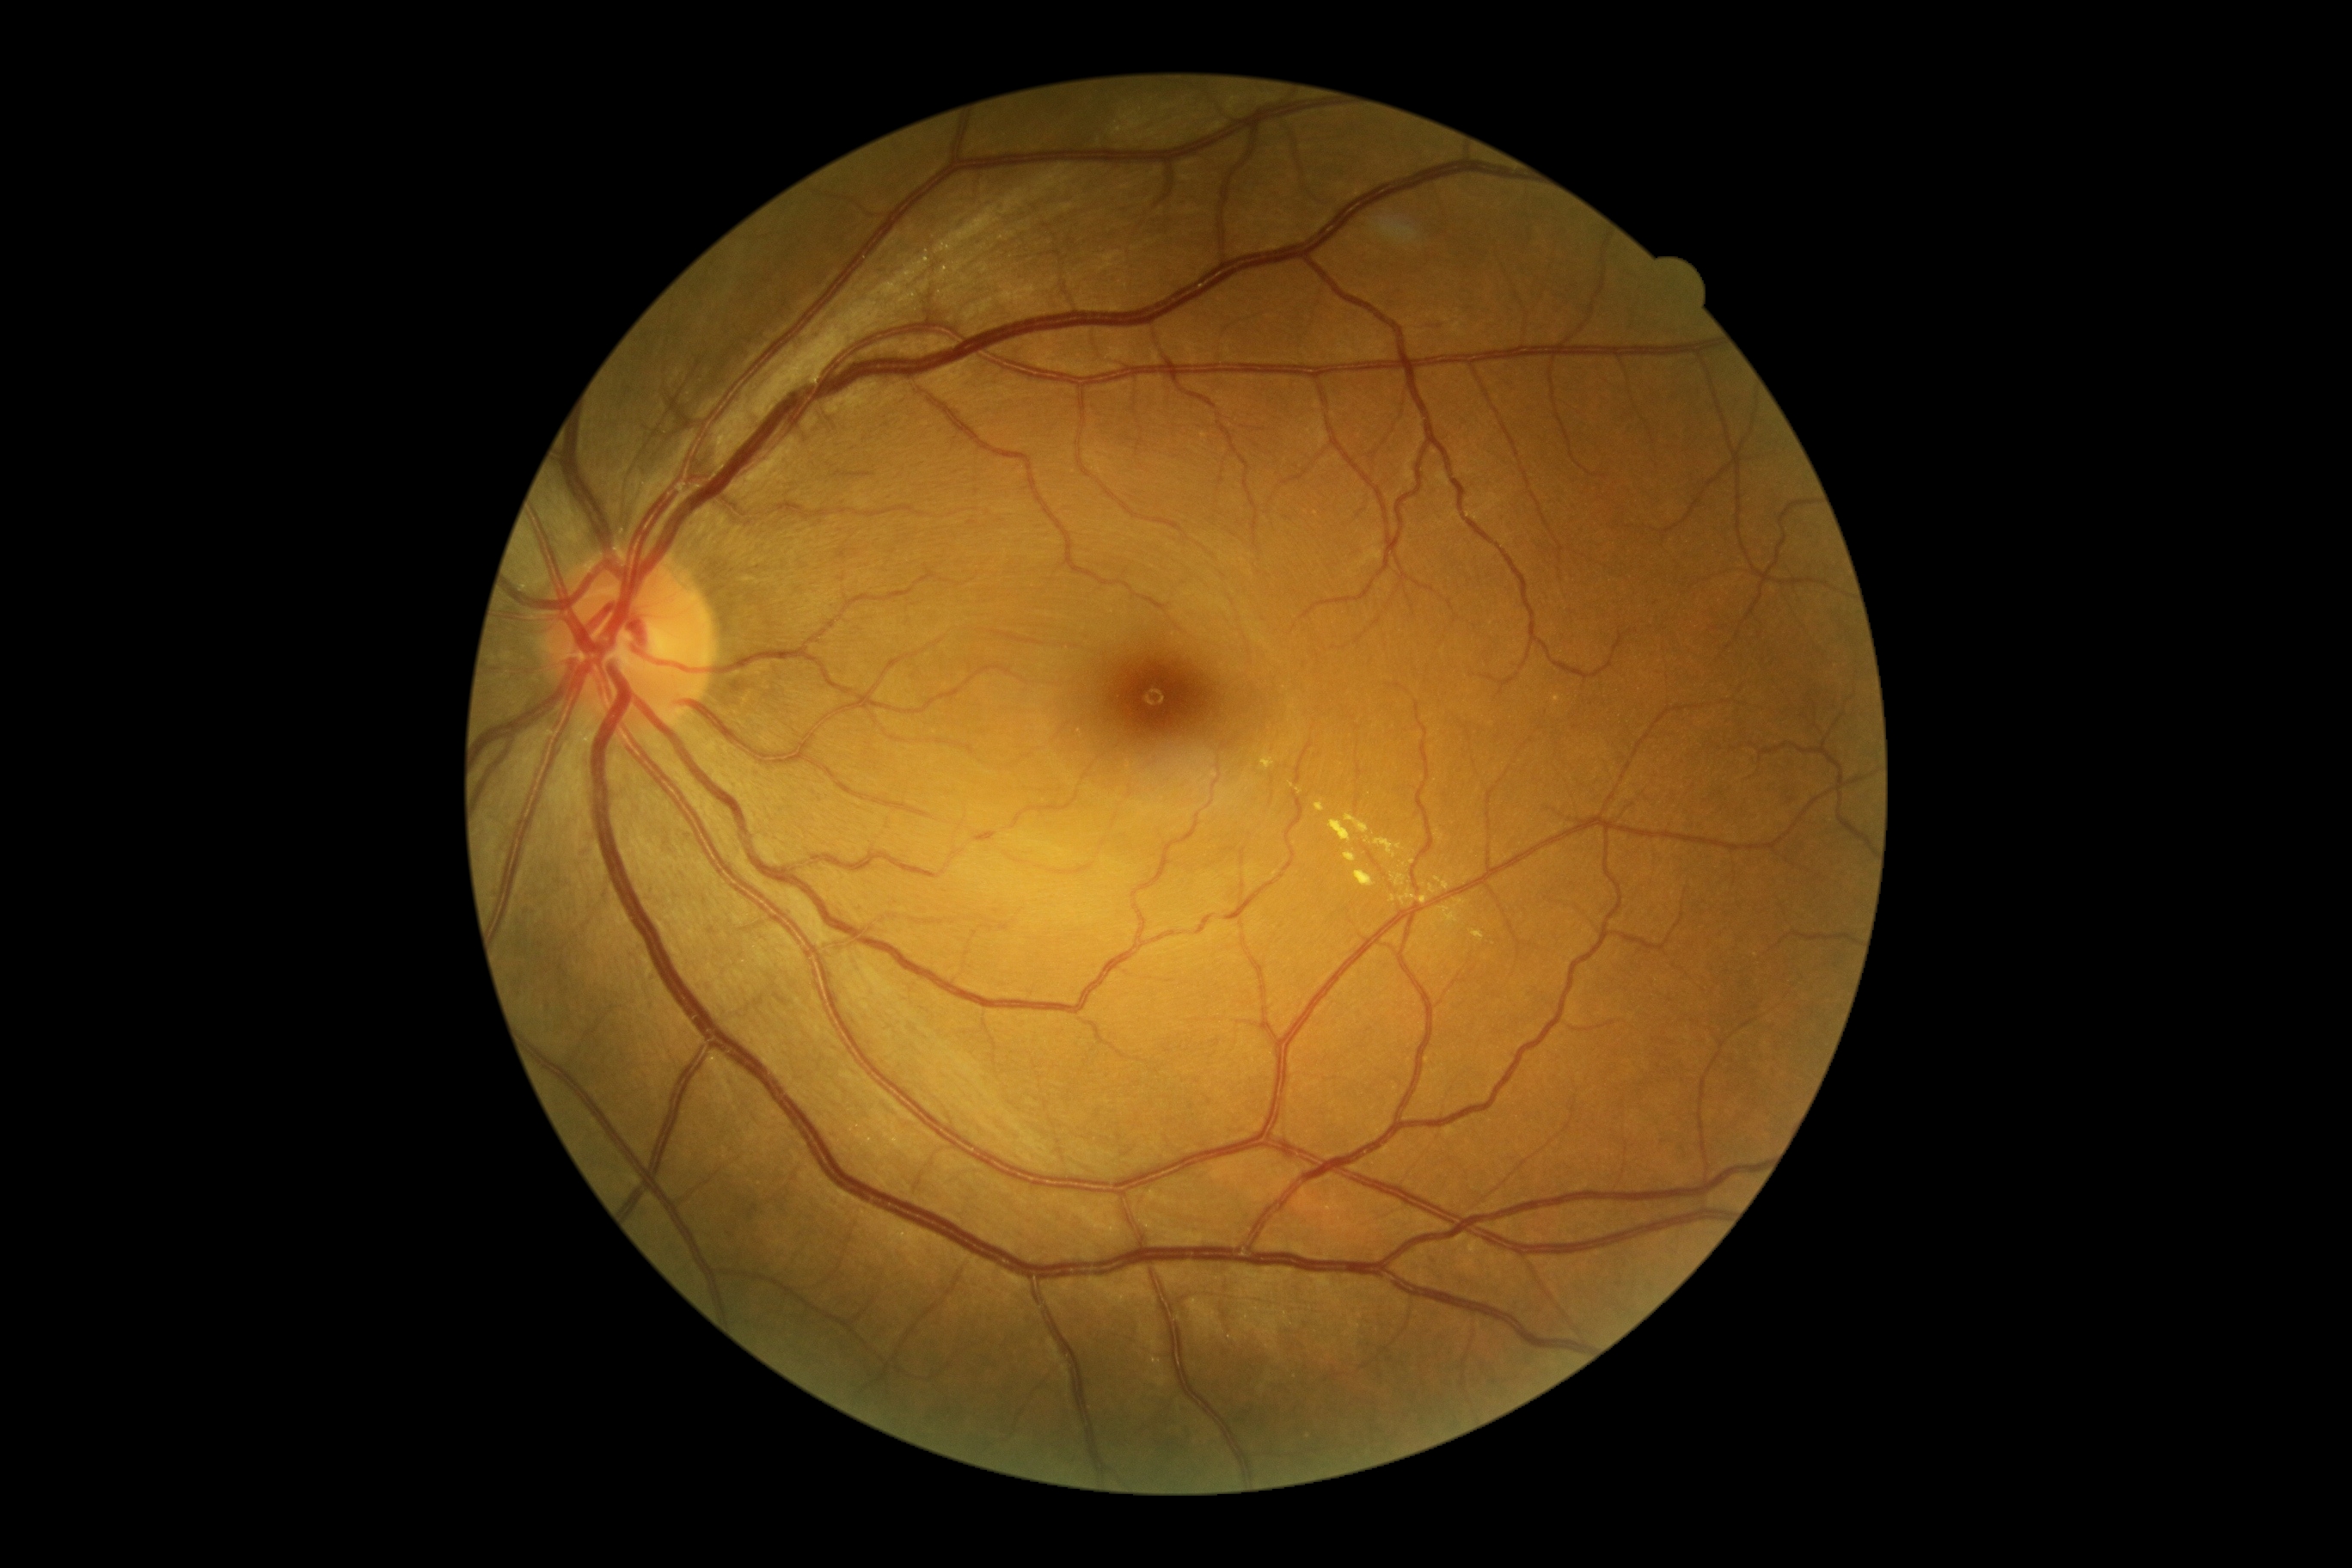

Disease class: non-proliferative diabetic retinopathy.
DR grade is moderate non-proliferative diabetic retinopathy (2).